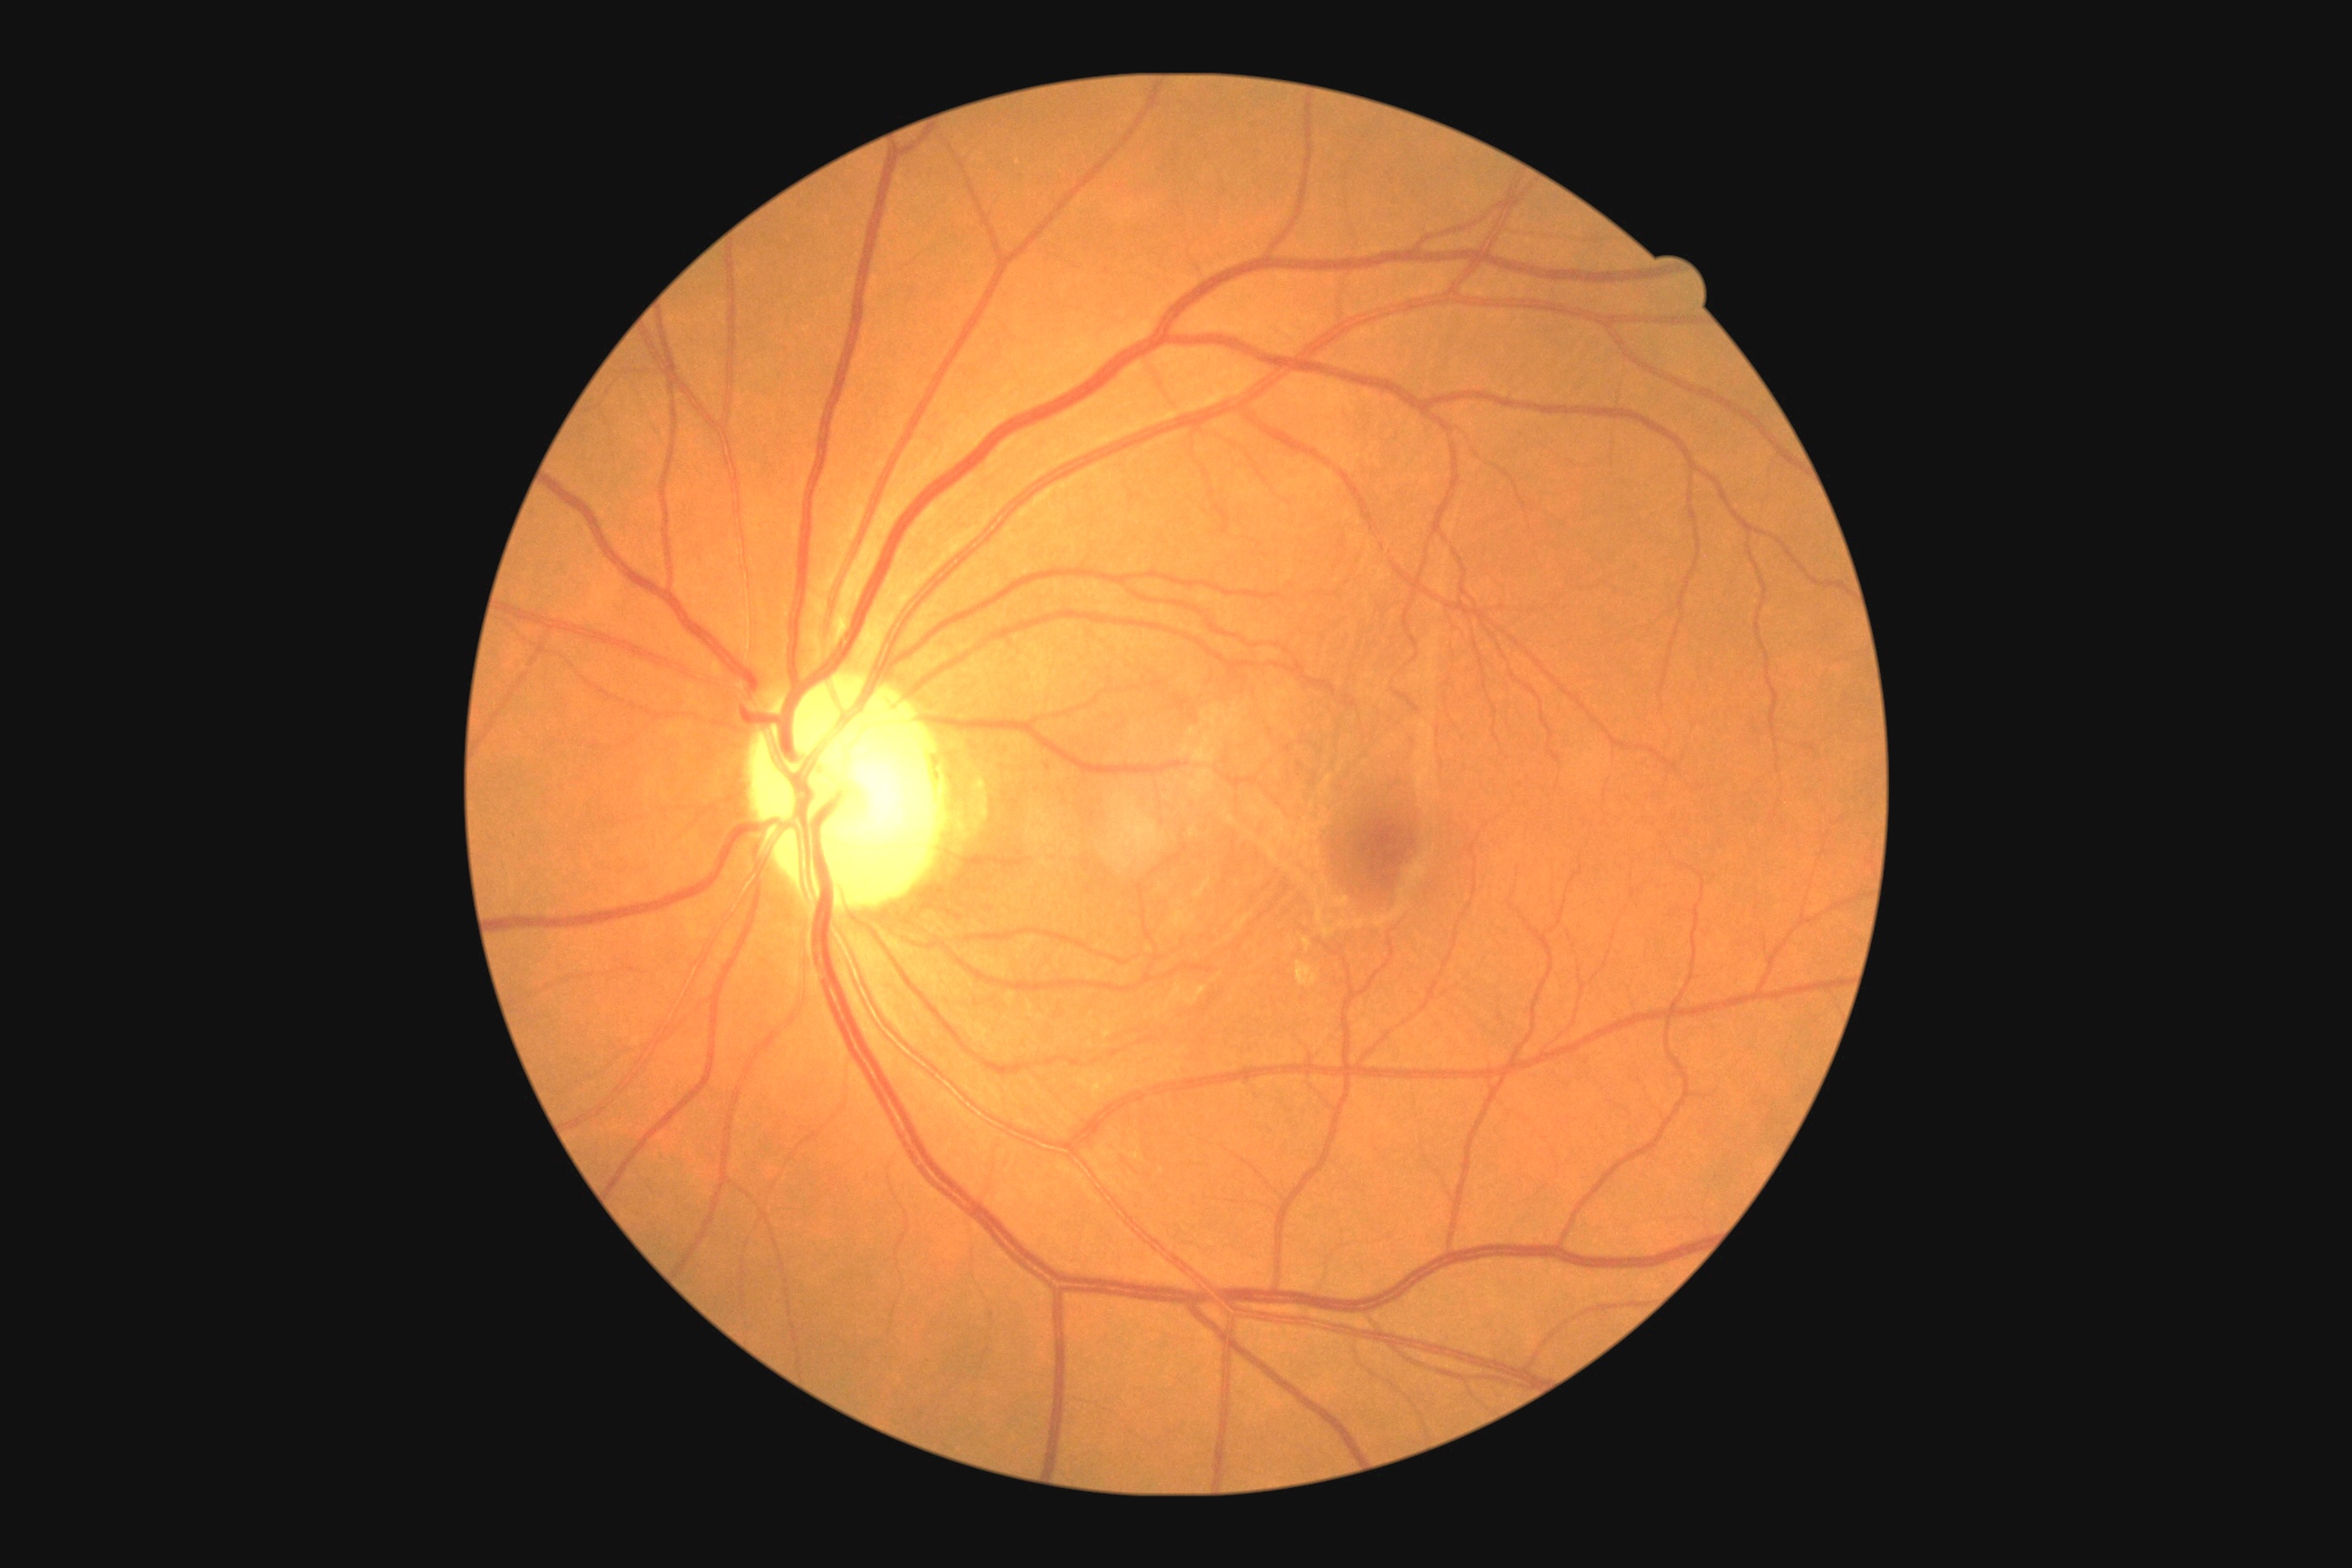
{"dr_grade": "grade 1"}